Color fundus image: 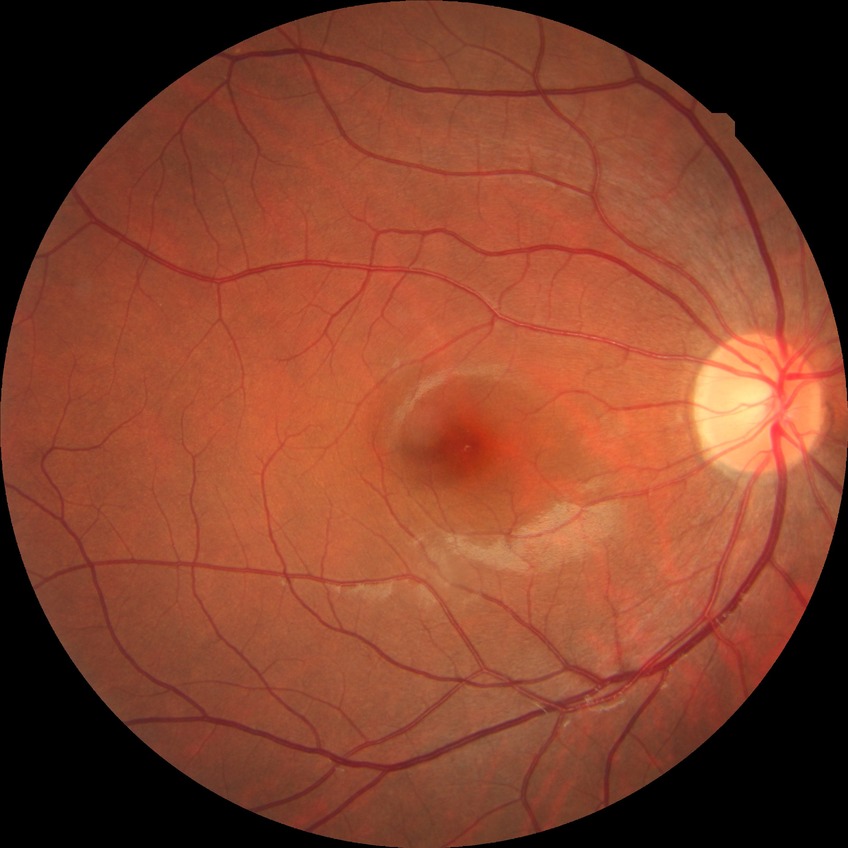
diabetic retinopathy (DR) = NDR (no diabetic retinopathy).